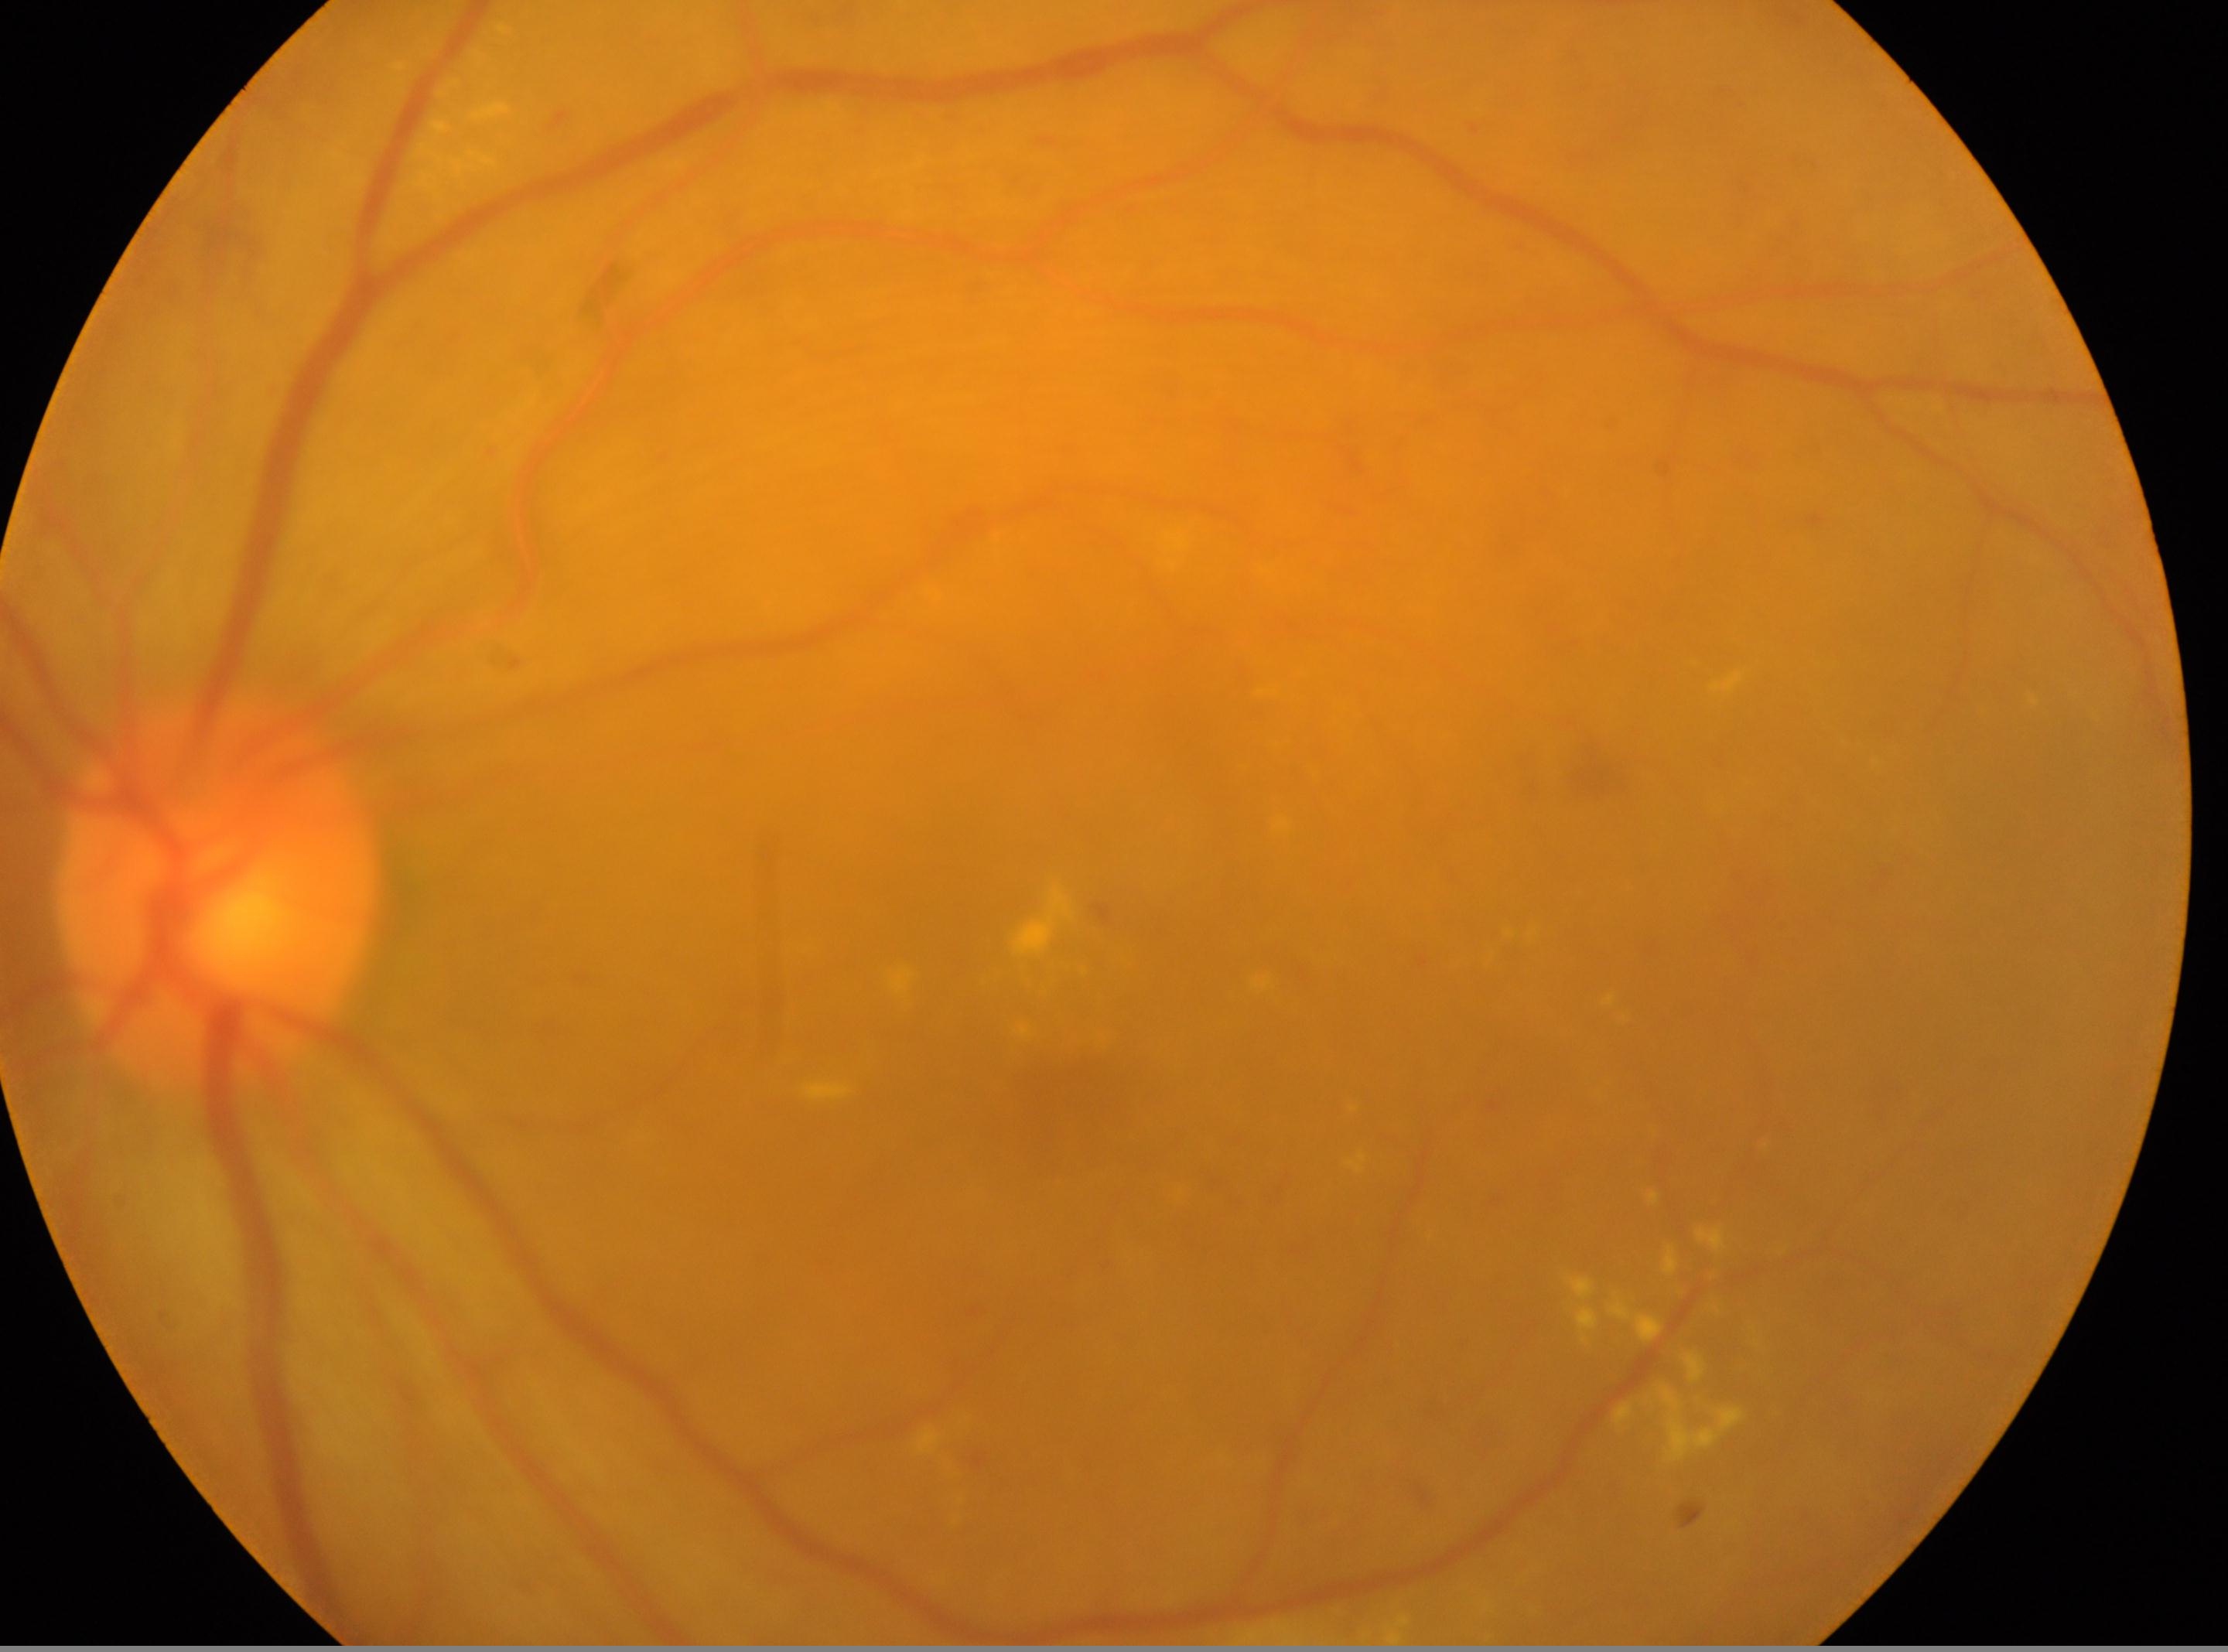
DR grade: 2 — more than just microaneurysms but less than severe NPDR.
Imaged eye: OS.
Disc center: x=220, y=893.
Foveal center located at x=1063, y=1095.